Camera: NIDEK AFC-230. Color fundus image: 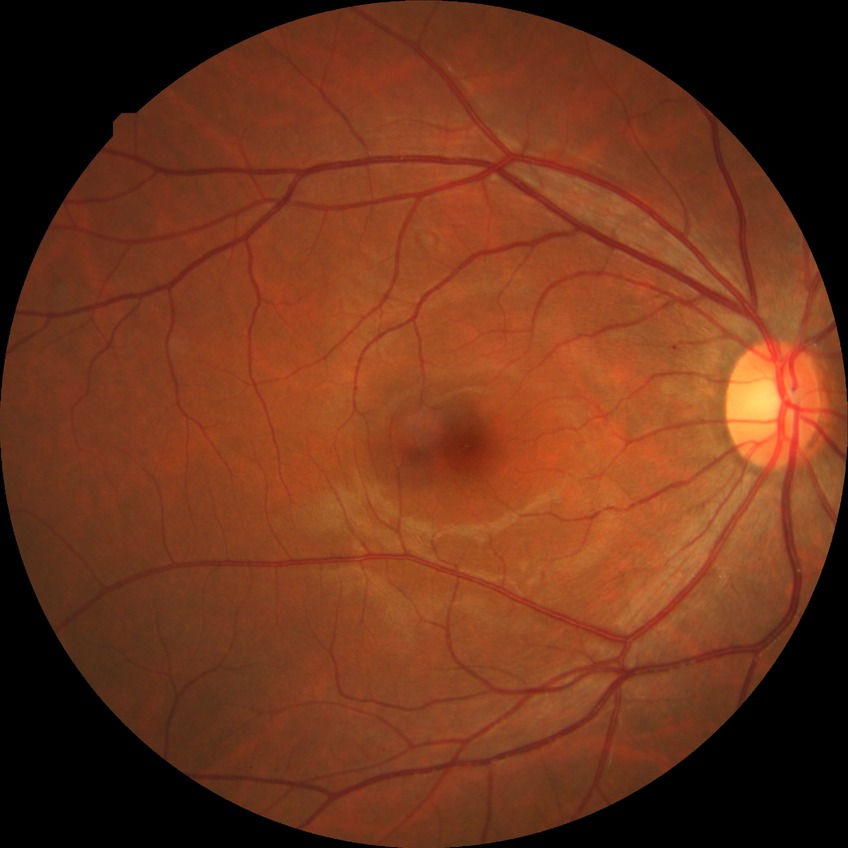

Diabetic retinopathy (DR): simple diabetic retinopathy (SDR).